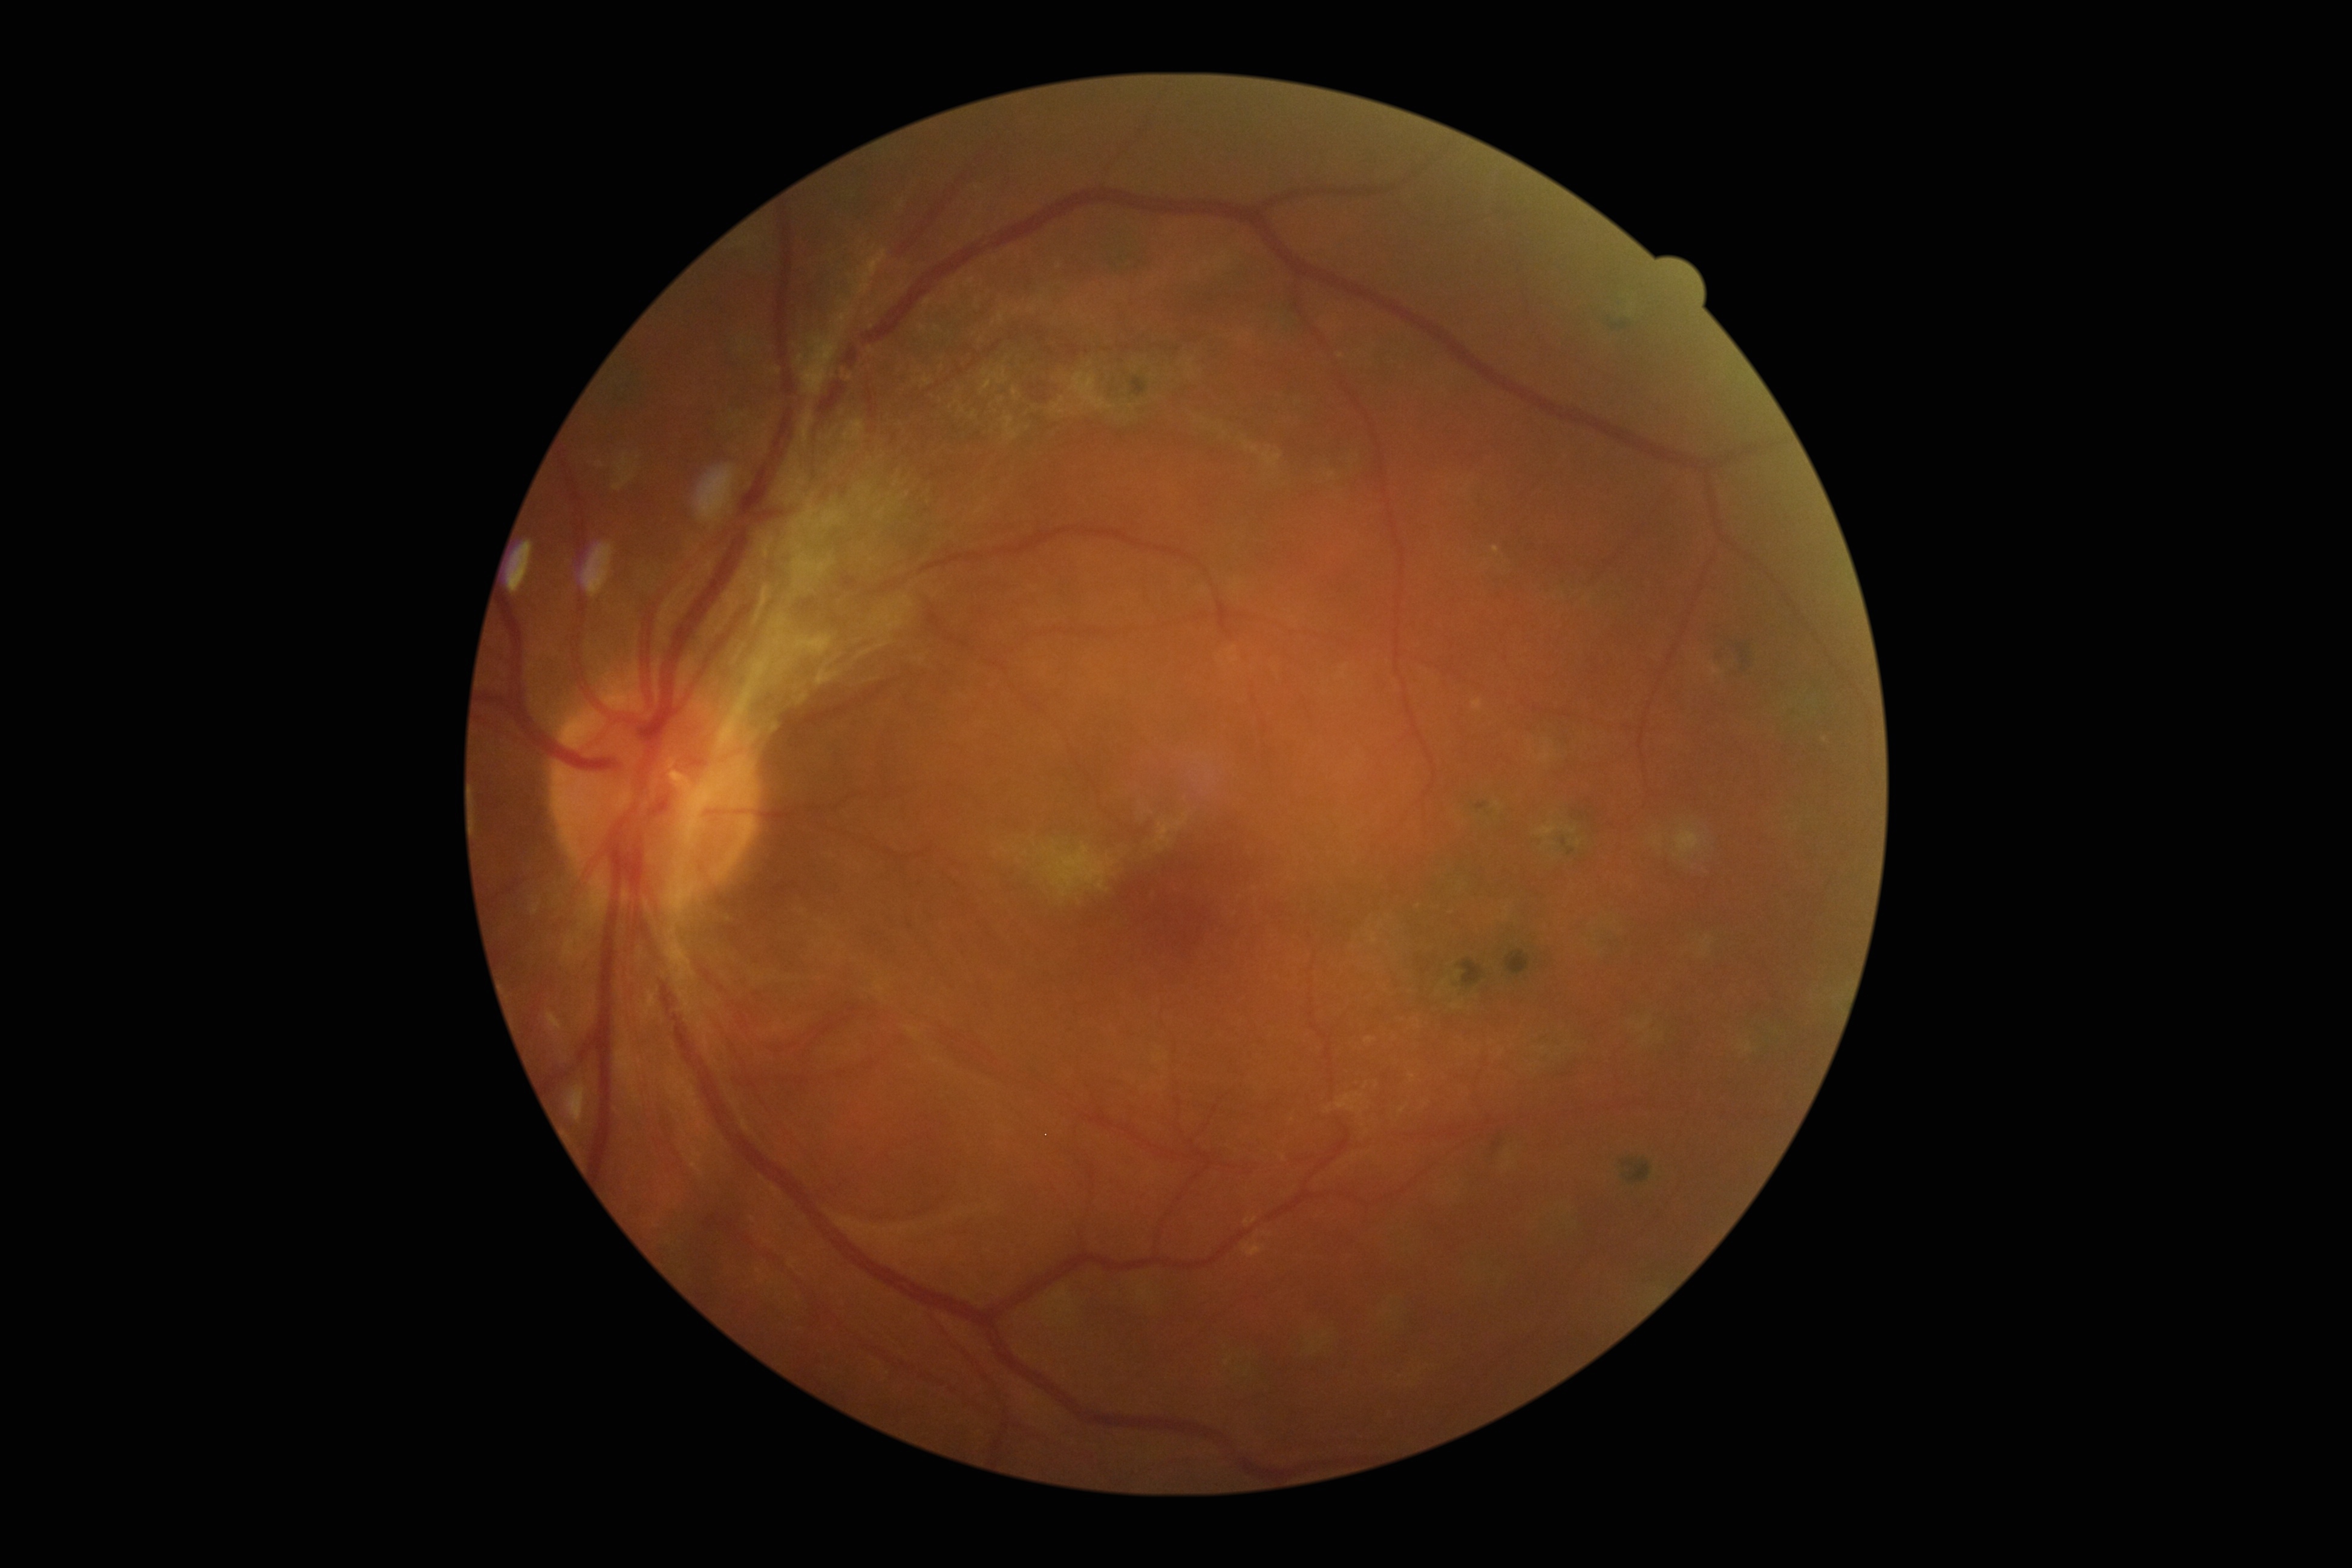
DR severity: proliferative diabetic retinopathy (grade 4).